1725 by 1721 pixels: 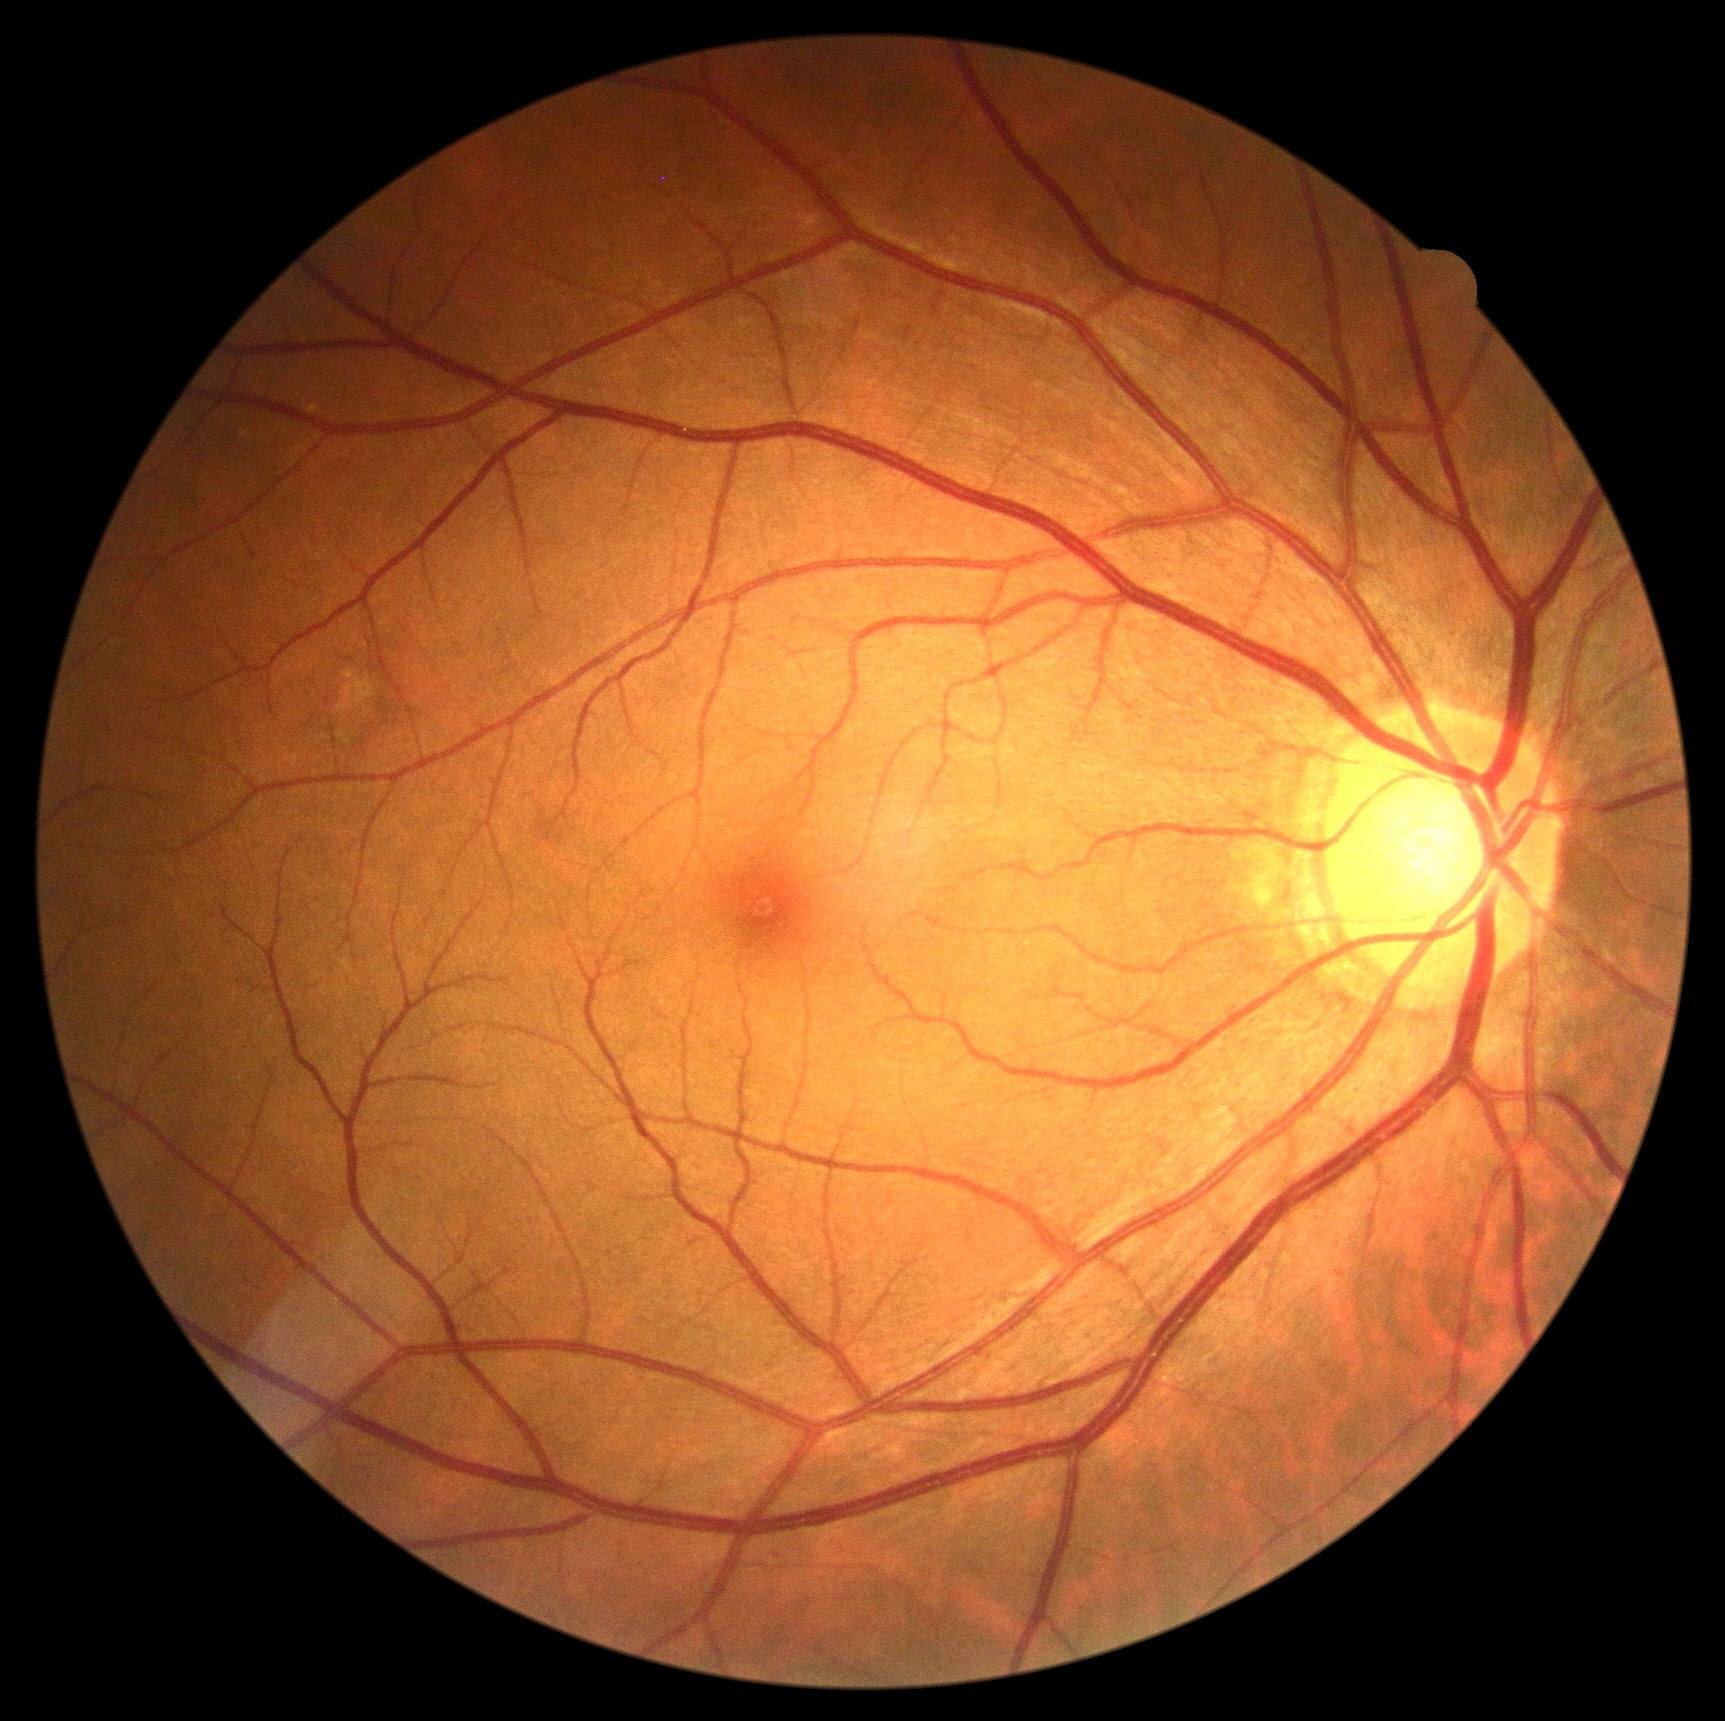 No apparent diabetic retinopathy. DR stage: 0/4.